Infant wide-field fundus photograph. Captured with the Natus RetCam Envision (130° field of view).
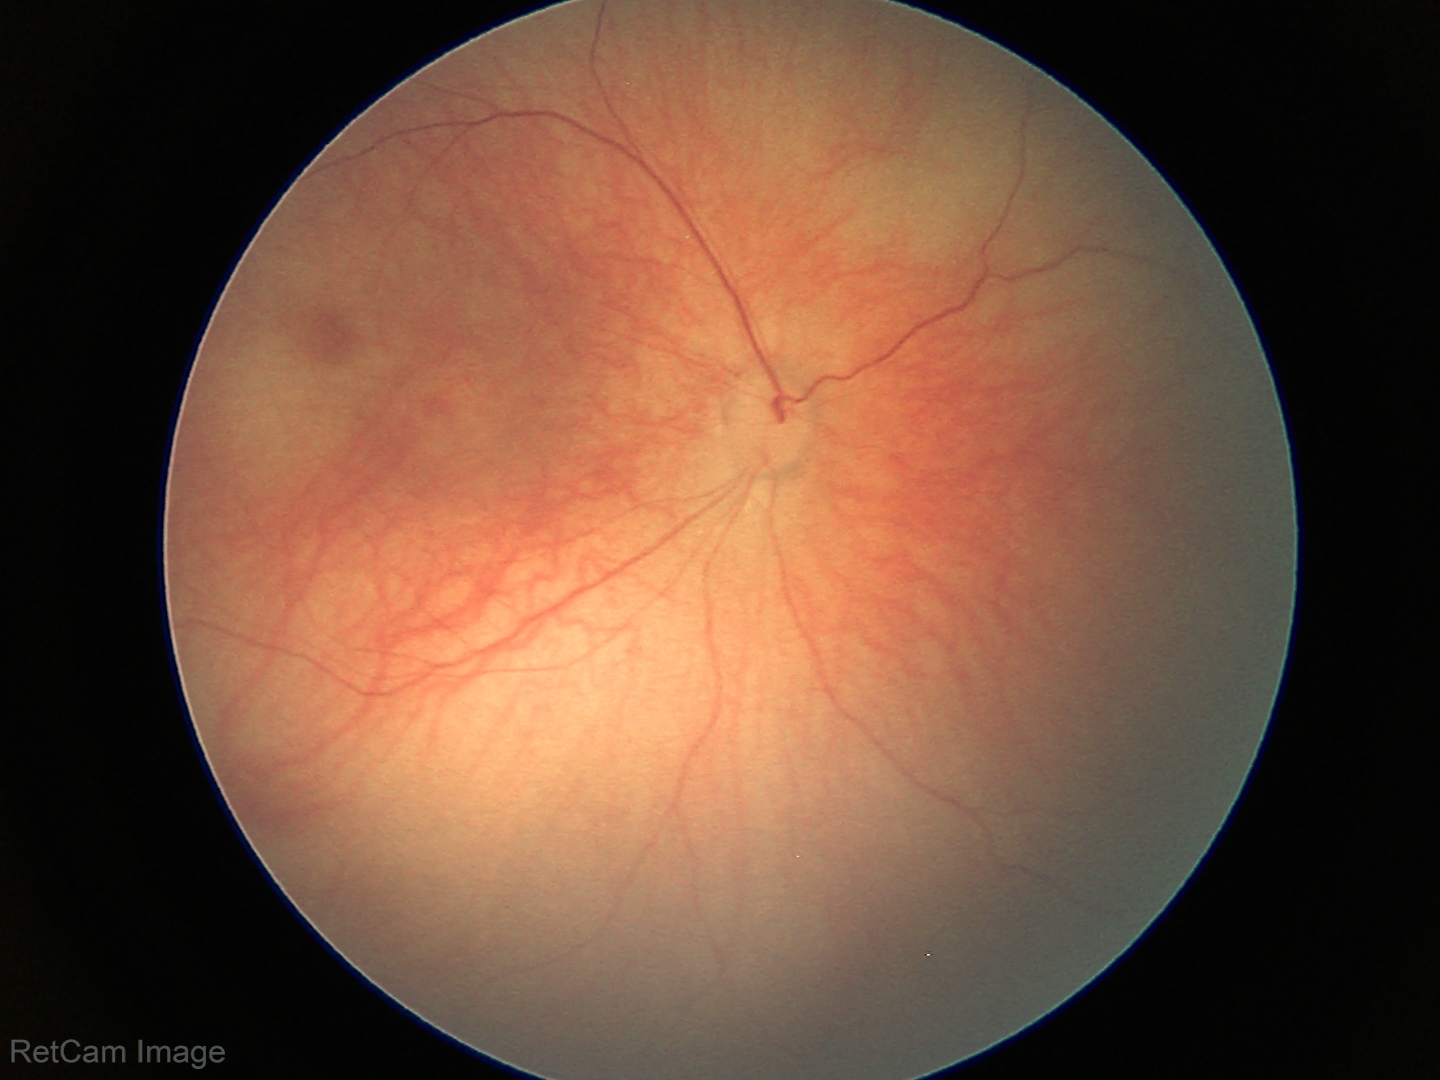
Physiological retinal appearance for postconceptual age.